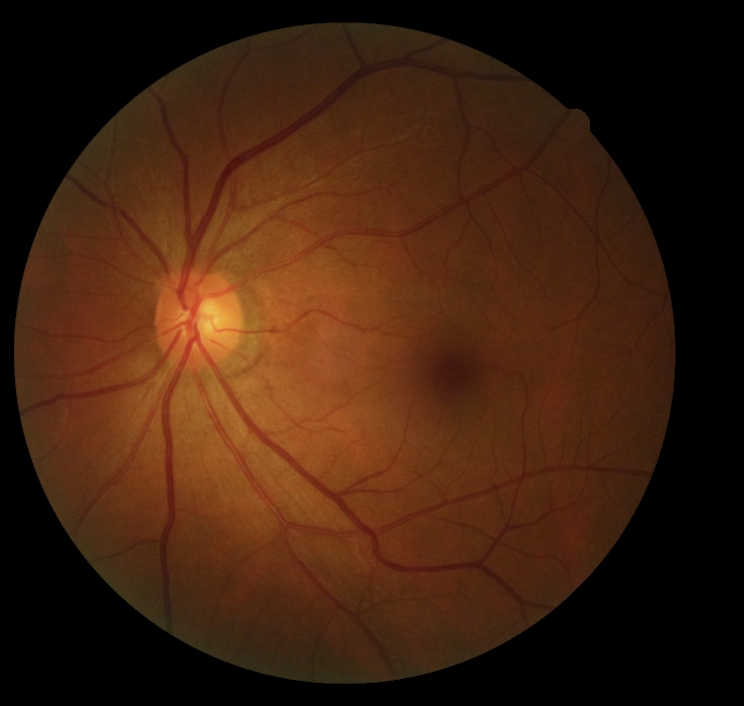 DR stage = no apparent diabetic retinopathy (grade 0).